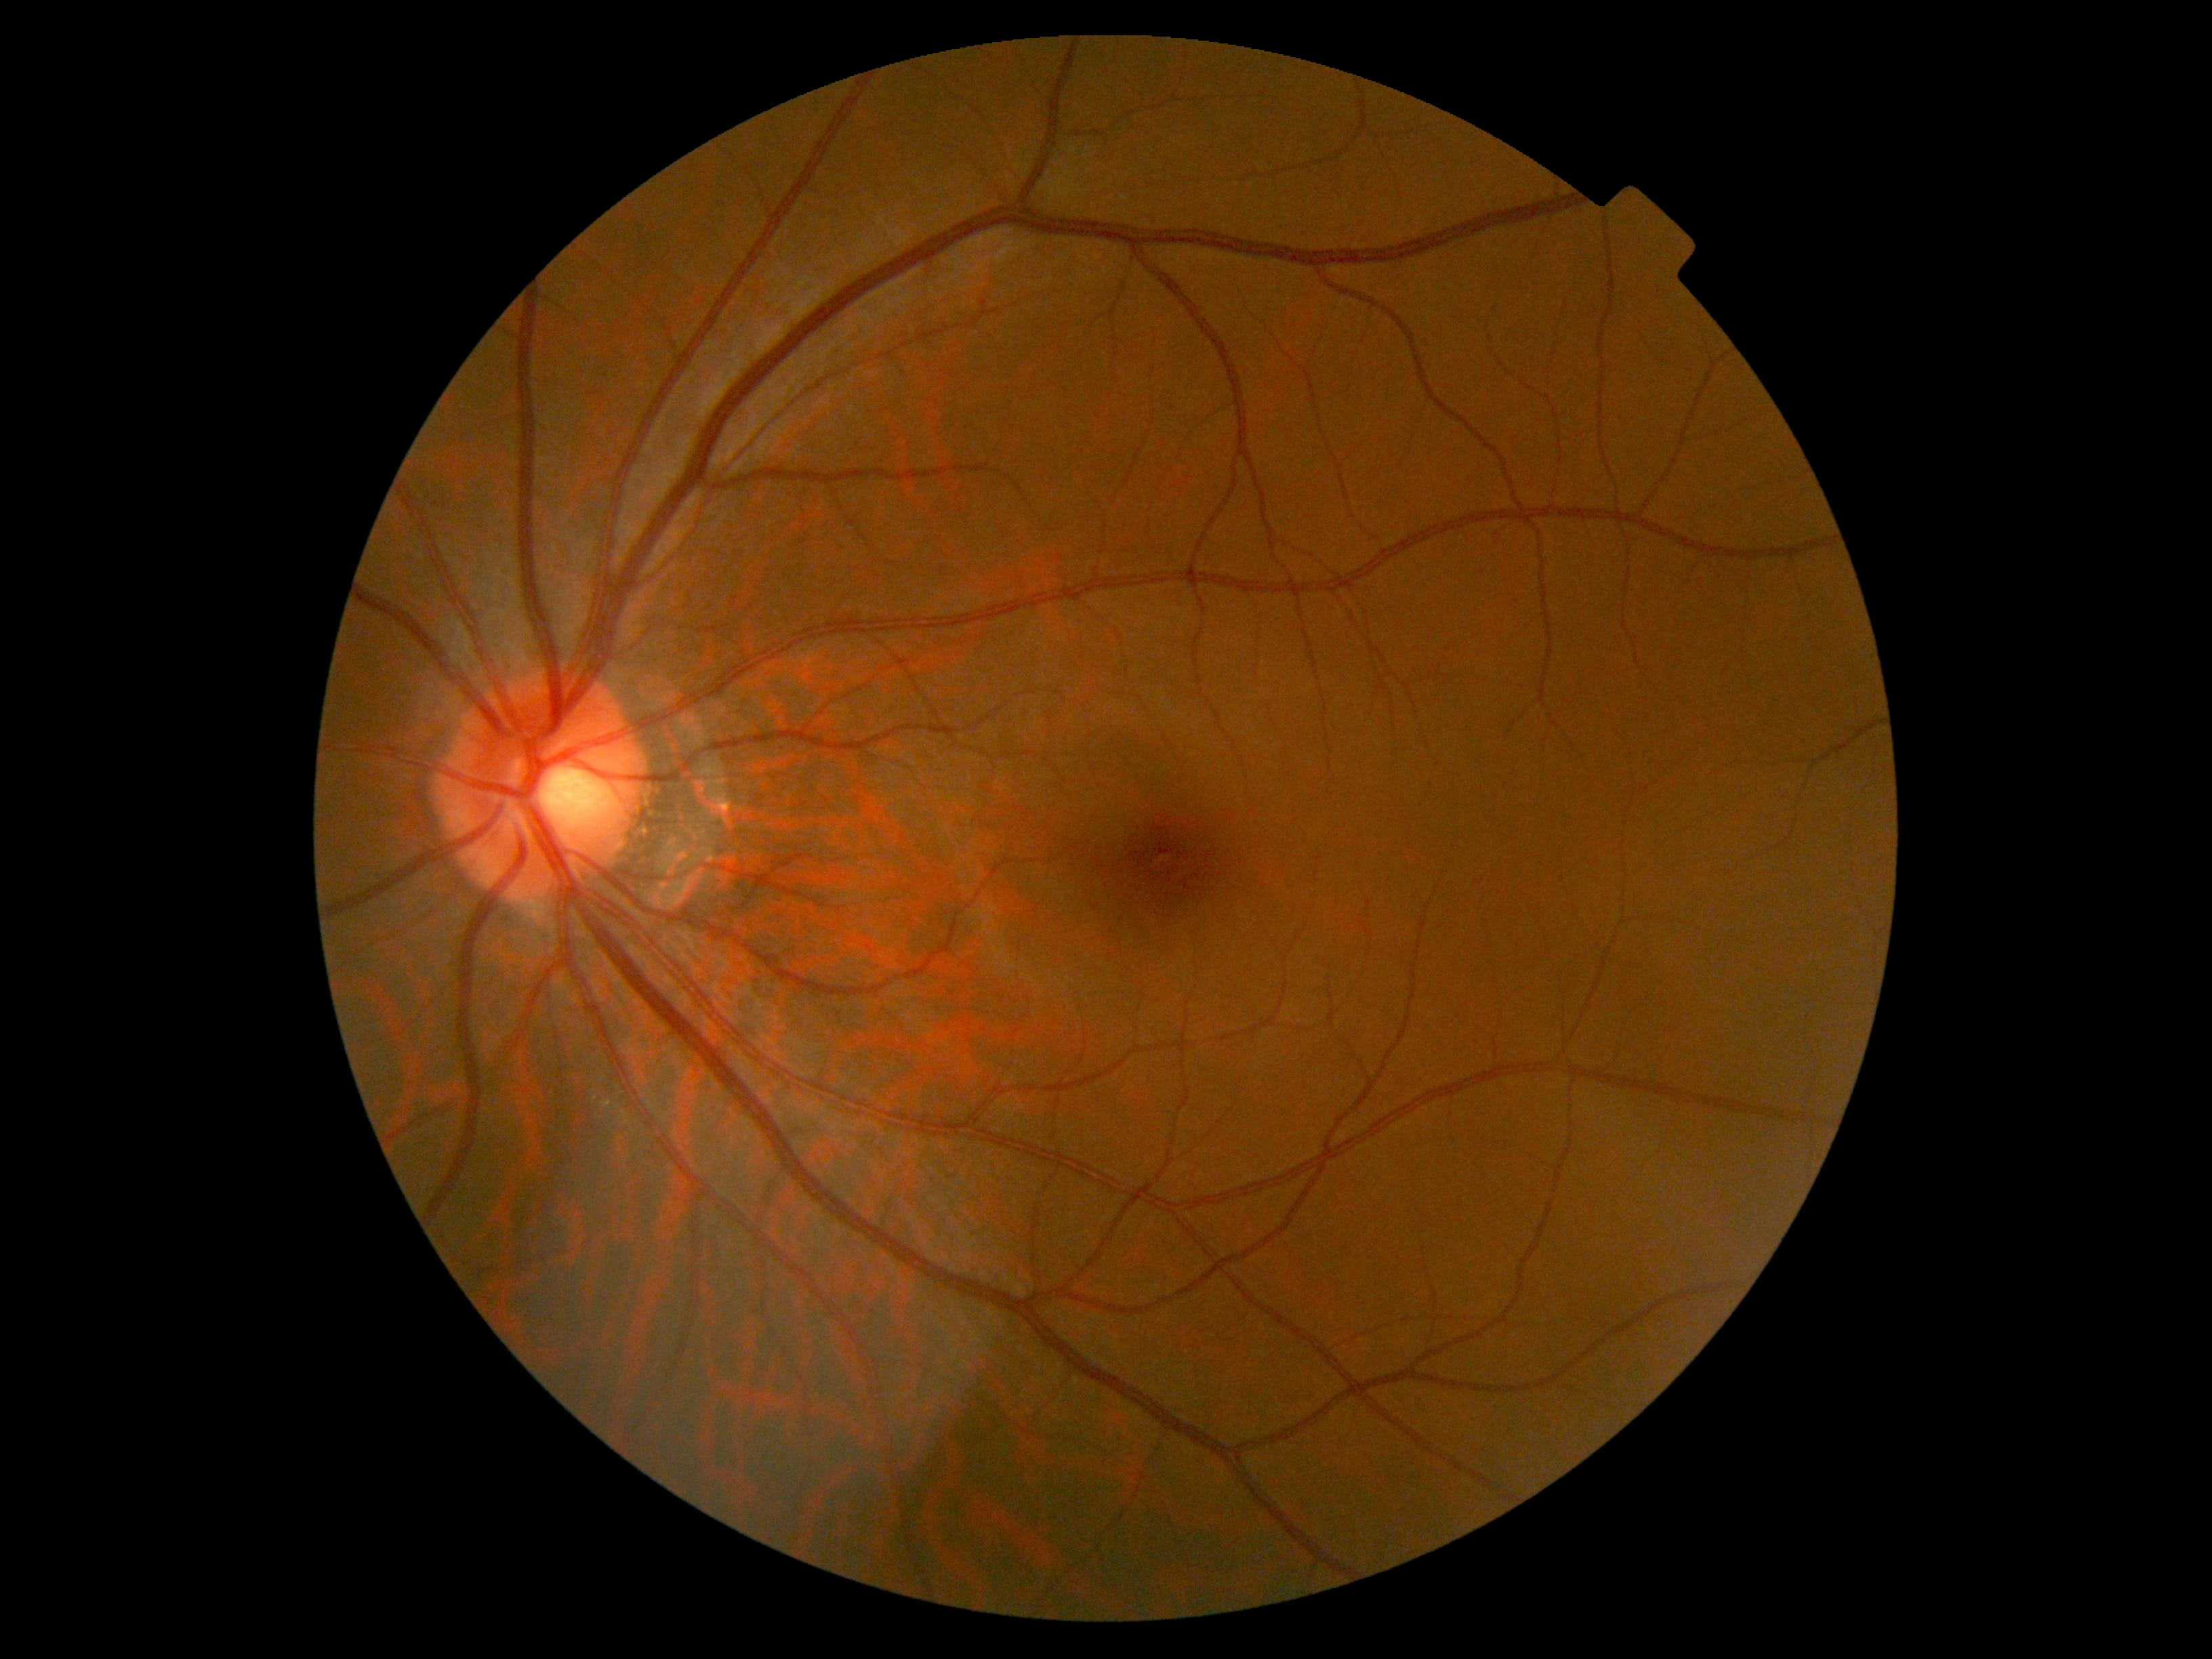

DR stage: grade 0 (no apparent retinopathy).